2048x1536px — 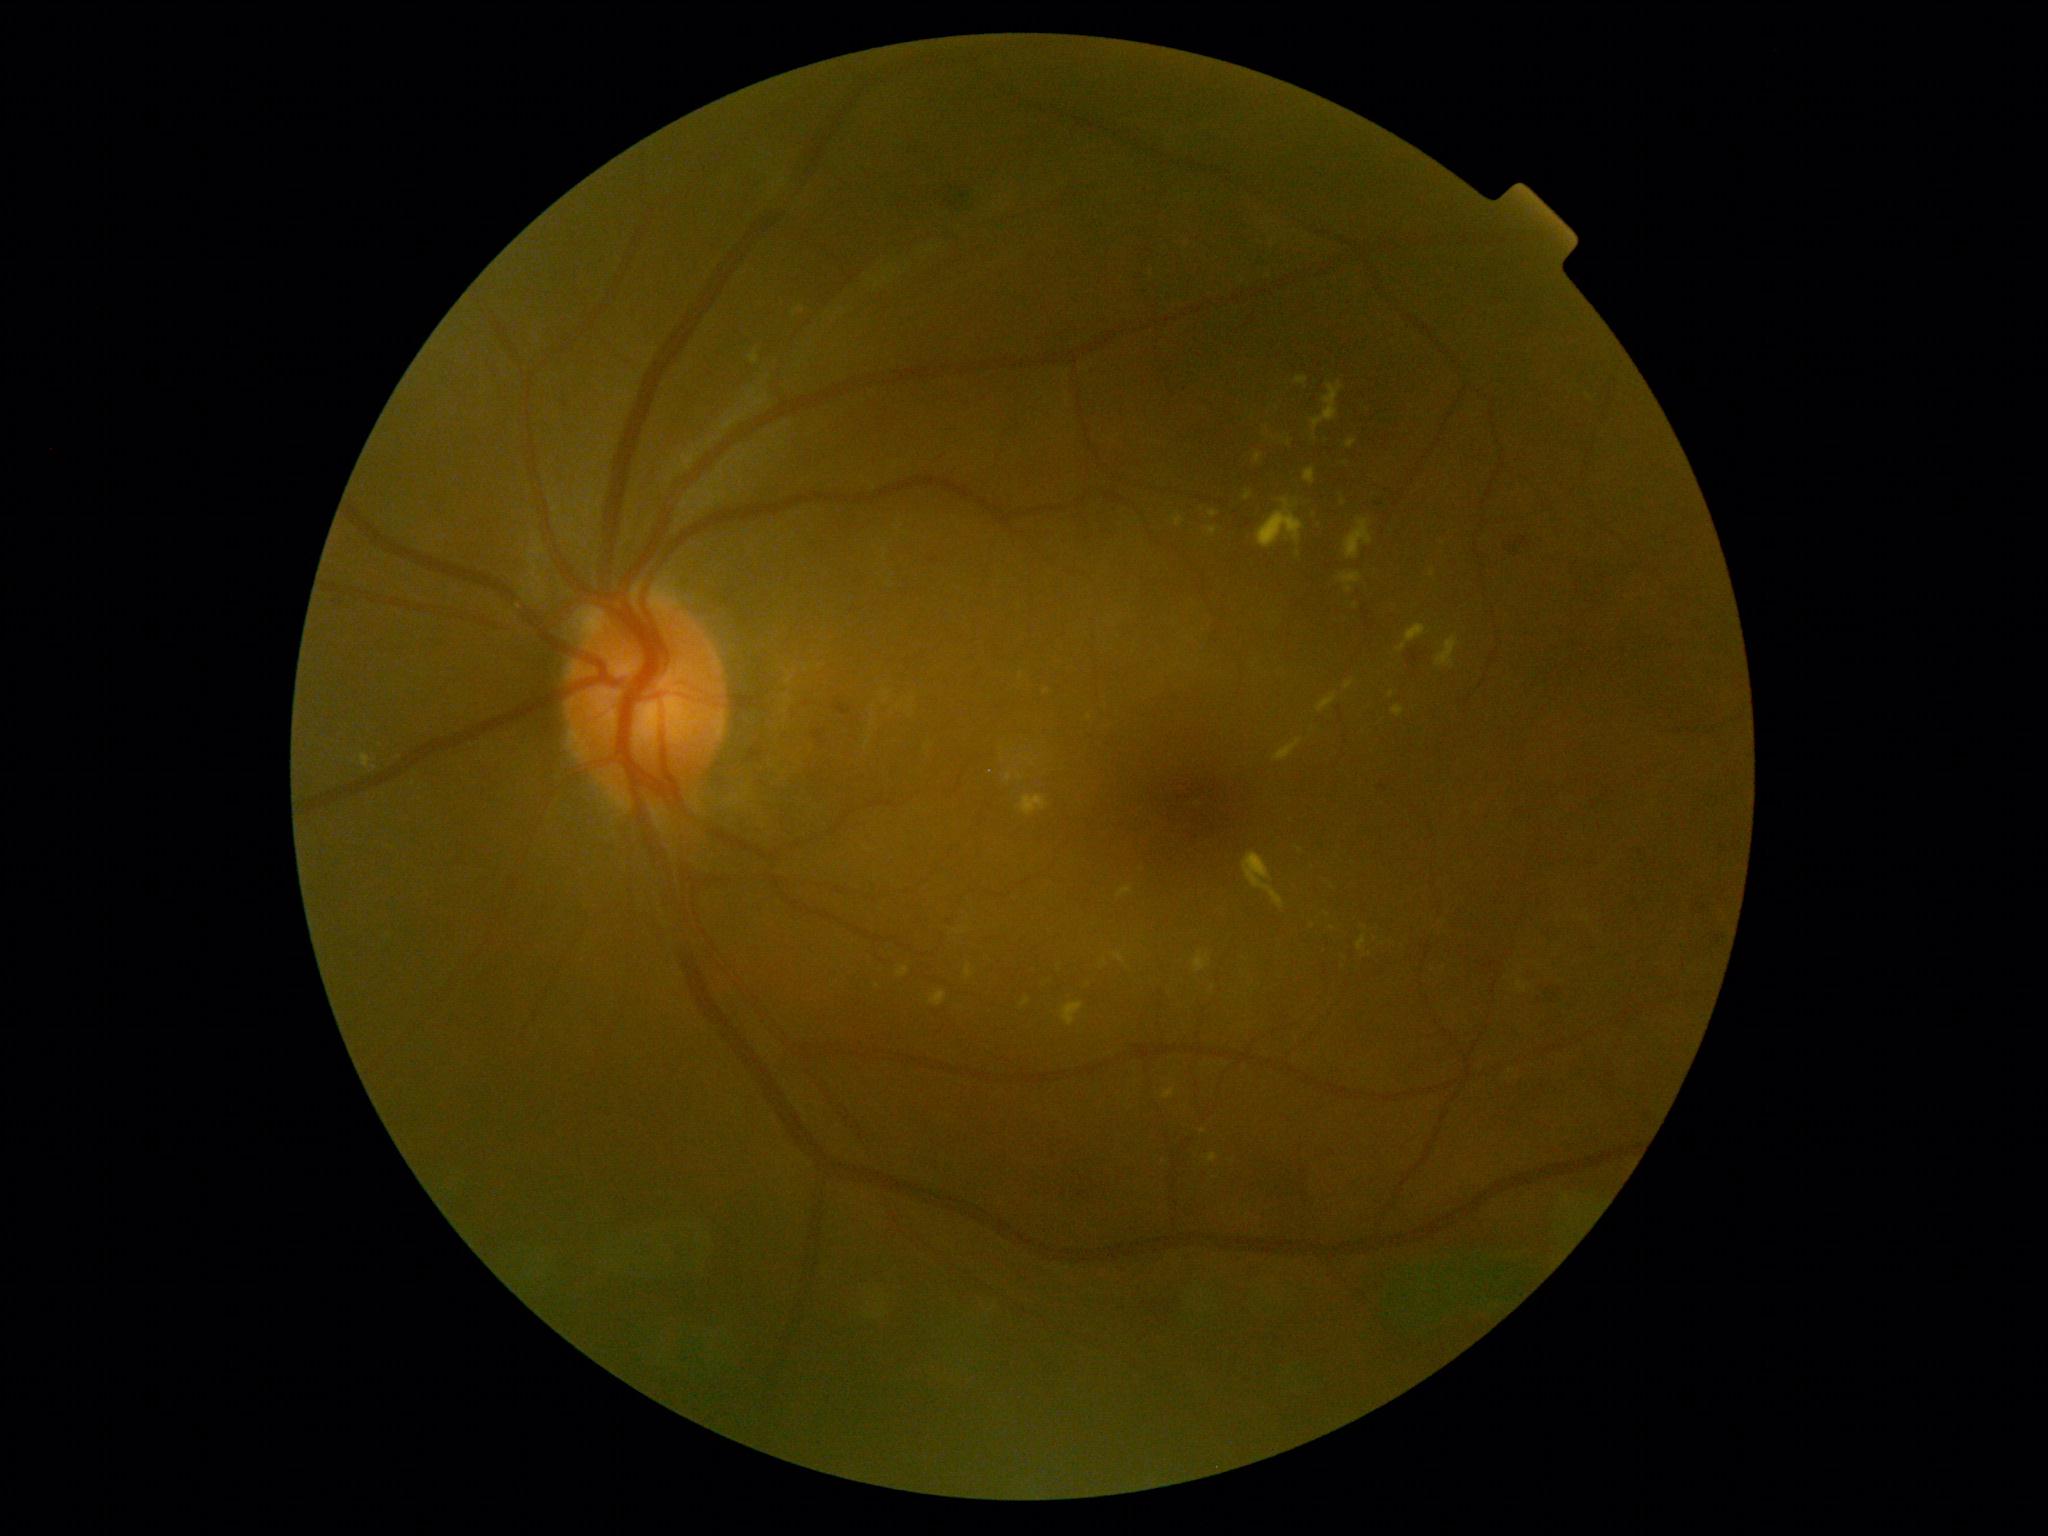
Diabetic retinopathy (DR): moderate NPDR (grade 2)
Representative lesions:
• hard exudates (EXs) (subset): [966,964,974,979] | [1257,498,1305,548] | [1338,573,1363,594] | [929,991,947,1007] | [1006,772,1013,782] | [1208,1153,1218,1163] | [1255,452,1264,464] | [1264,427,1277,440] | [1345,682,1354,689] | [1274,739,1302,762] | [1390,690,1394,699] | [1396,624,1427,653] | [1357,935,1367,951] | [897,966,908,978]
• Small EXs approximately at <point>1346, 463</point> | <point>1105, 962</point> | <point>1588, 397</point> | <point>1299, 555</point> | <point>1203, 1132</point>